Wide-field contact fundus photograph of an infant; 1440 by 1080 pixels: 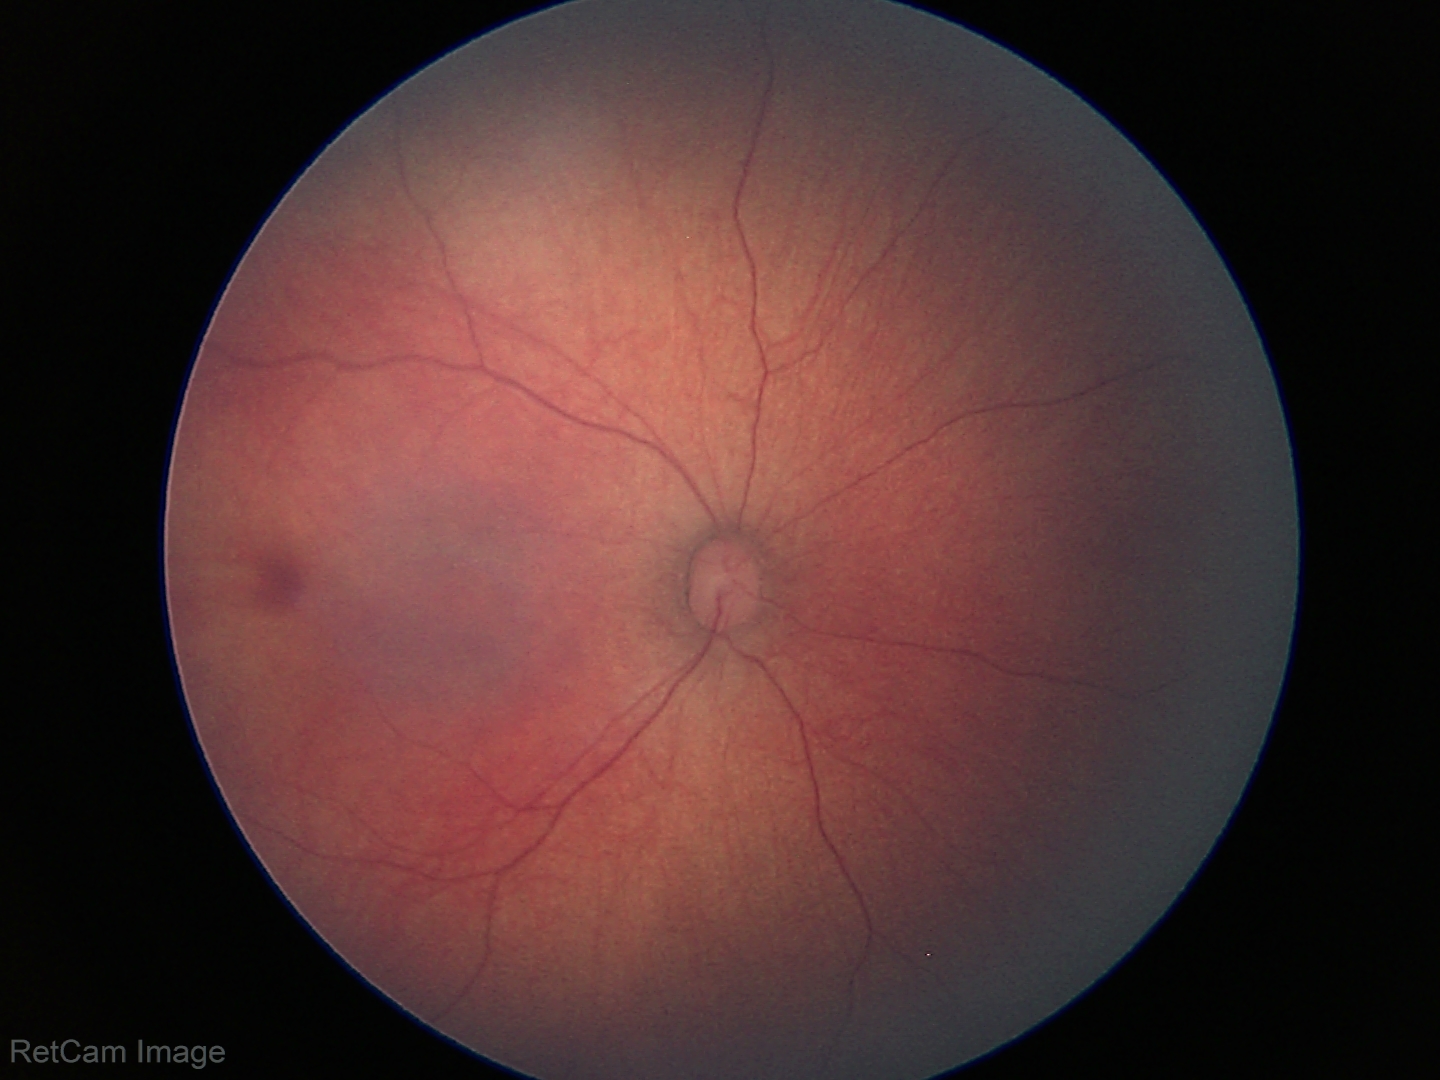 Assessment = physiological appearance.